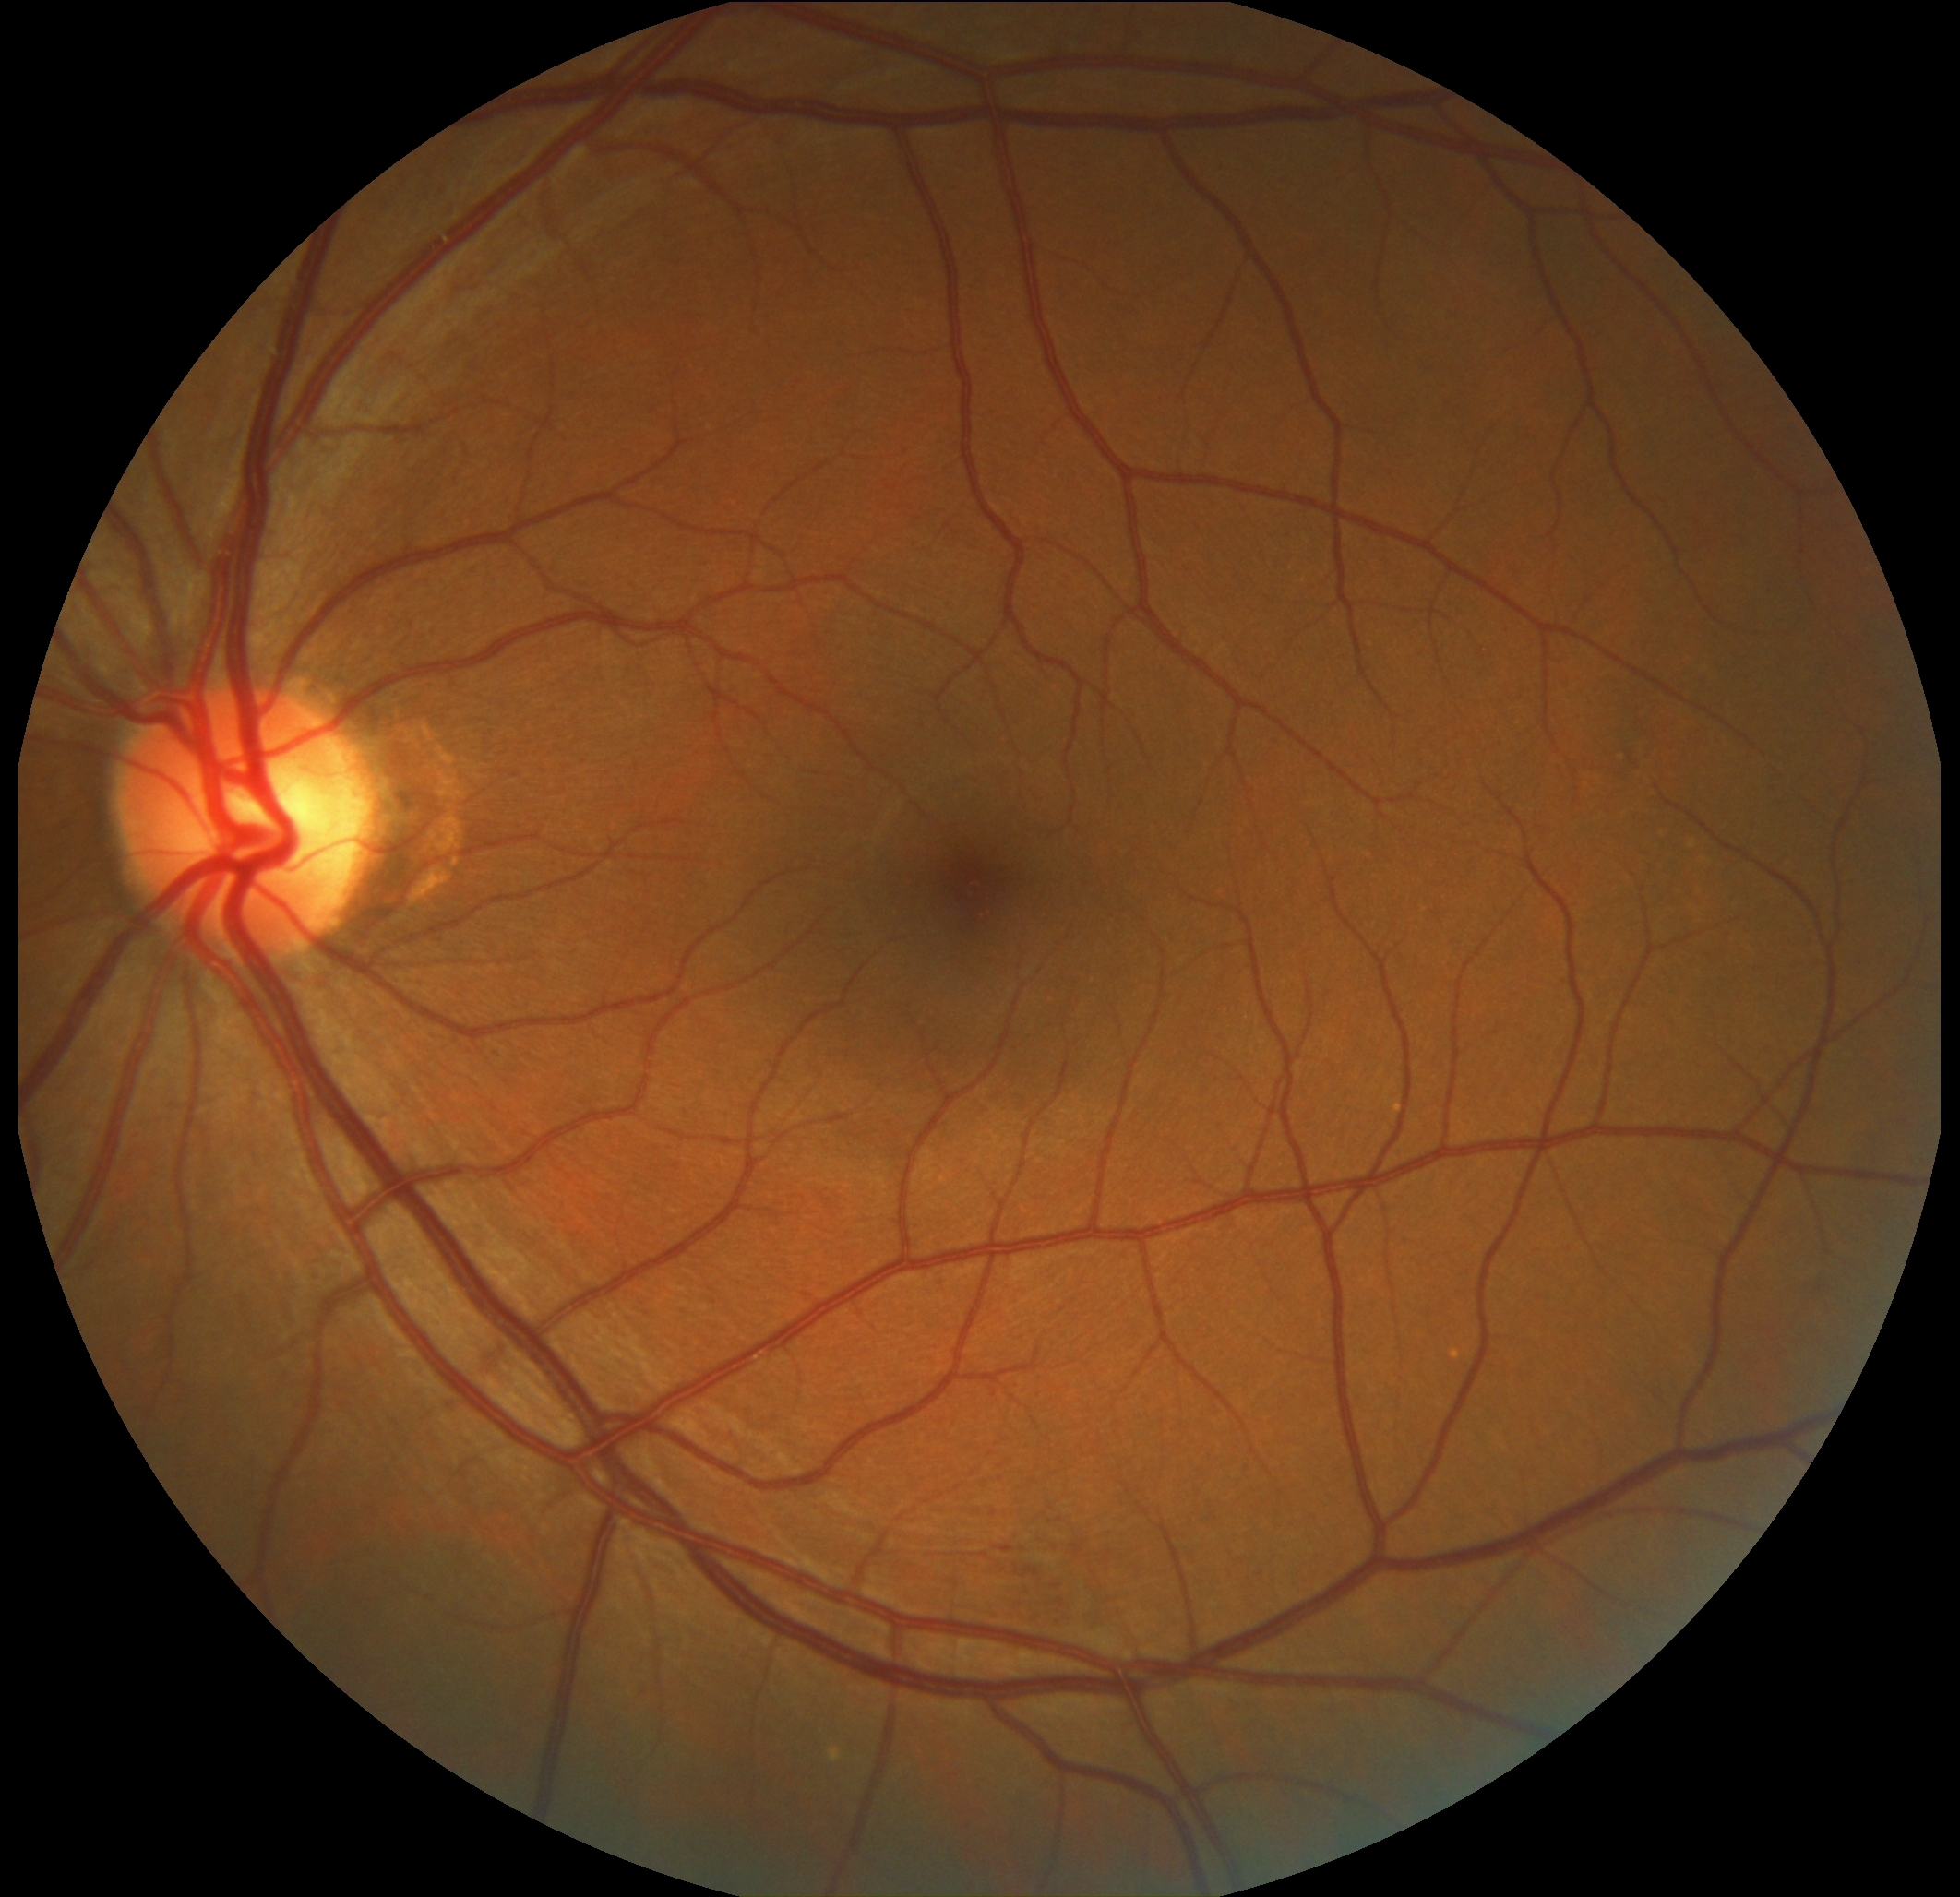 Diabetic retinopathy (DR): moderate non-proliferative diabetic retinopathy (grade 2).